Posterior pole photograph; no pharmacologic dilation: 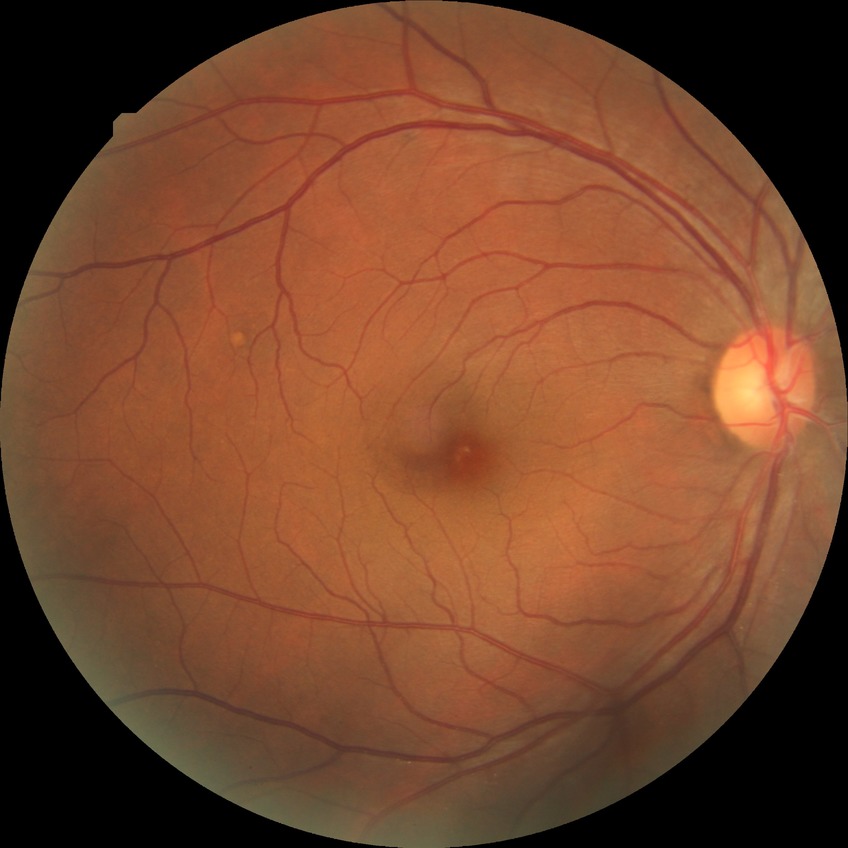

  davis_grade: NDR (no diabetic retinopathy)